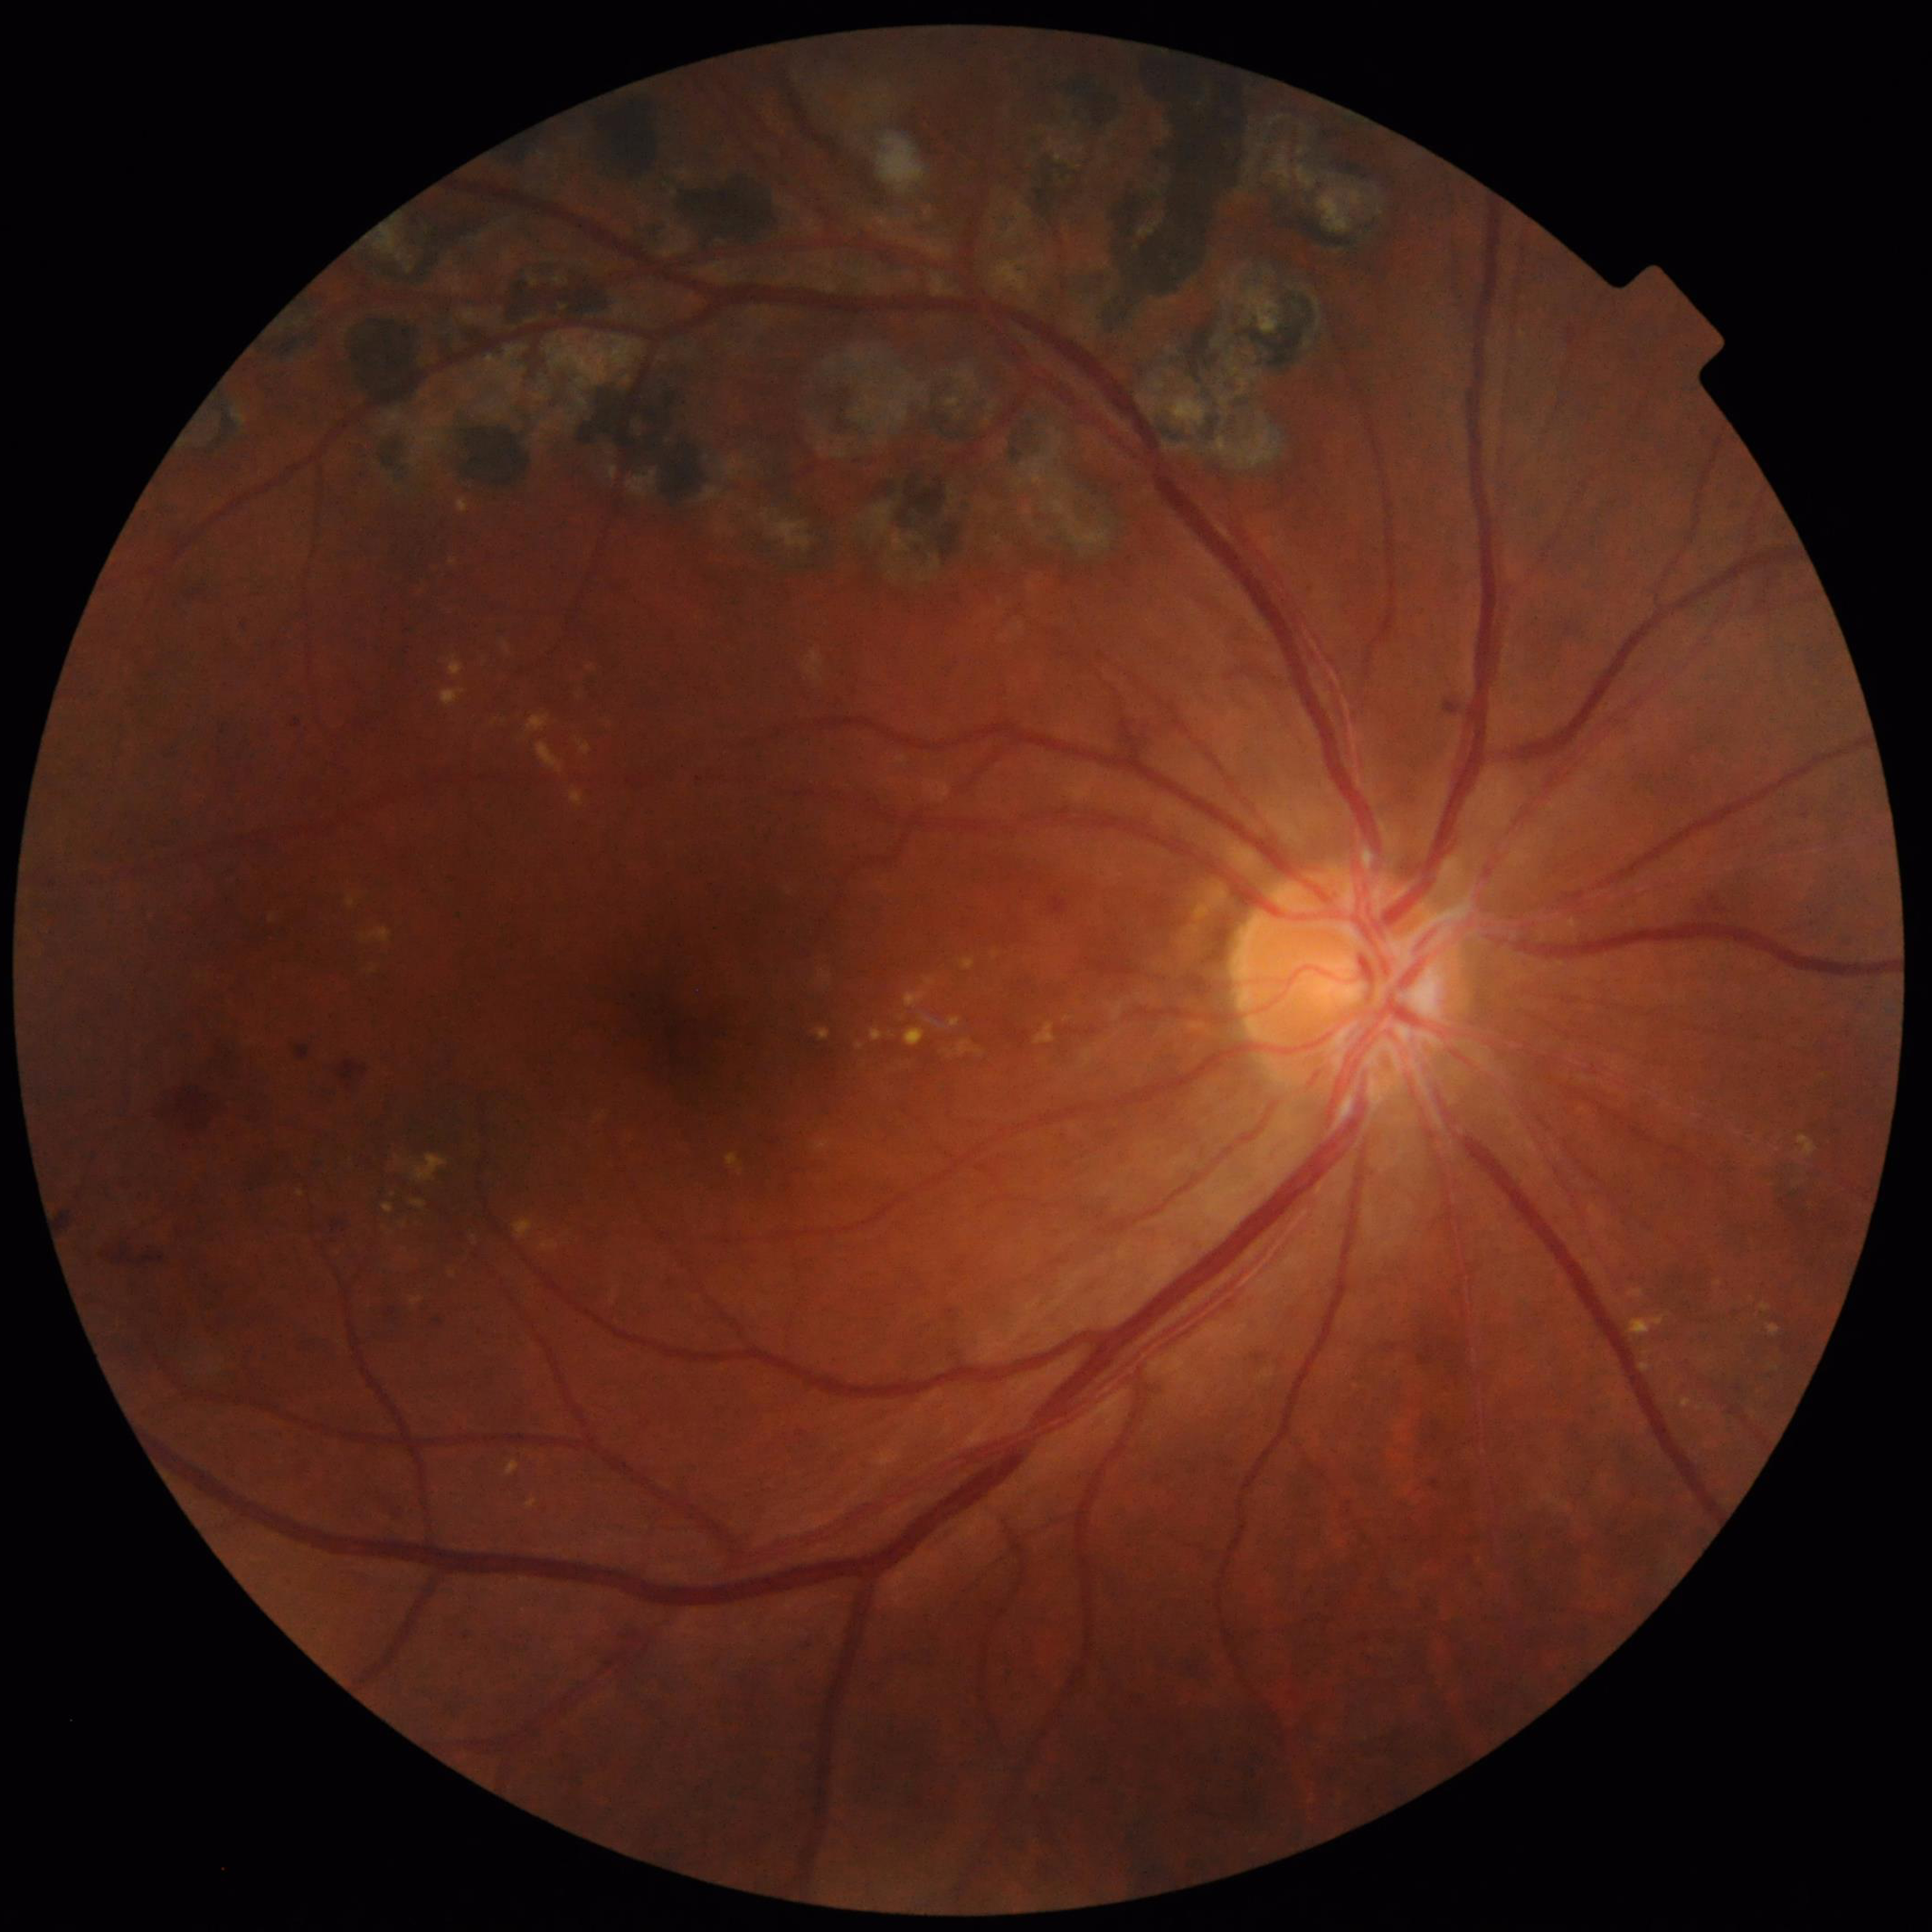

Disease class: DR.